Fundus photo.
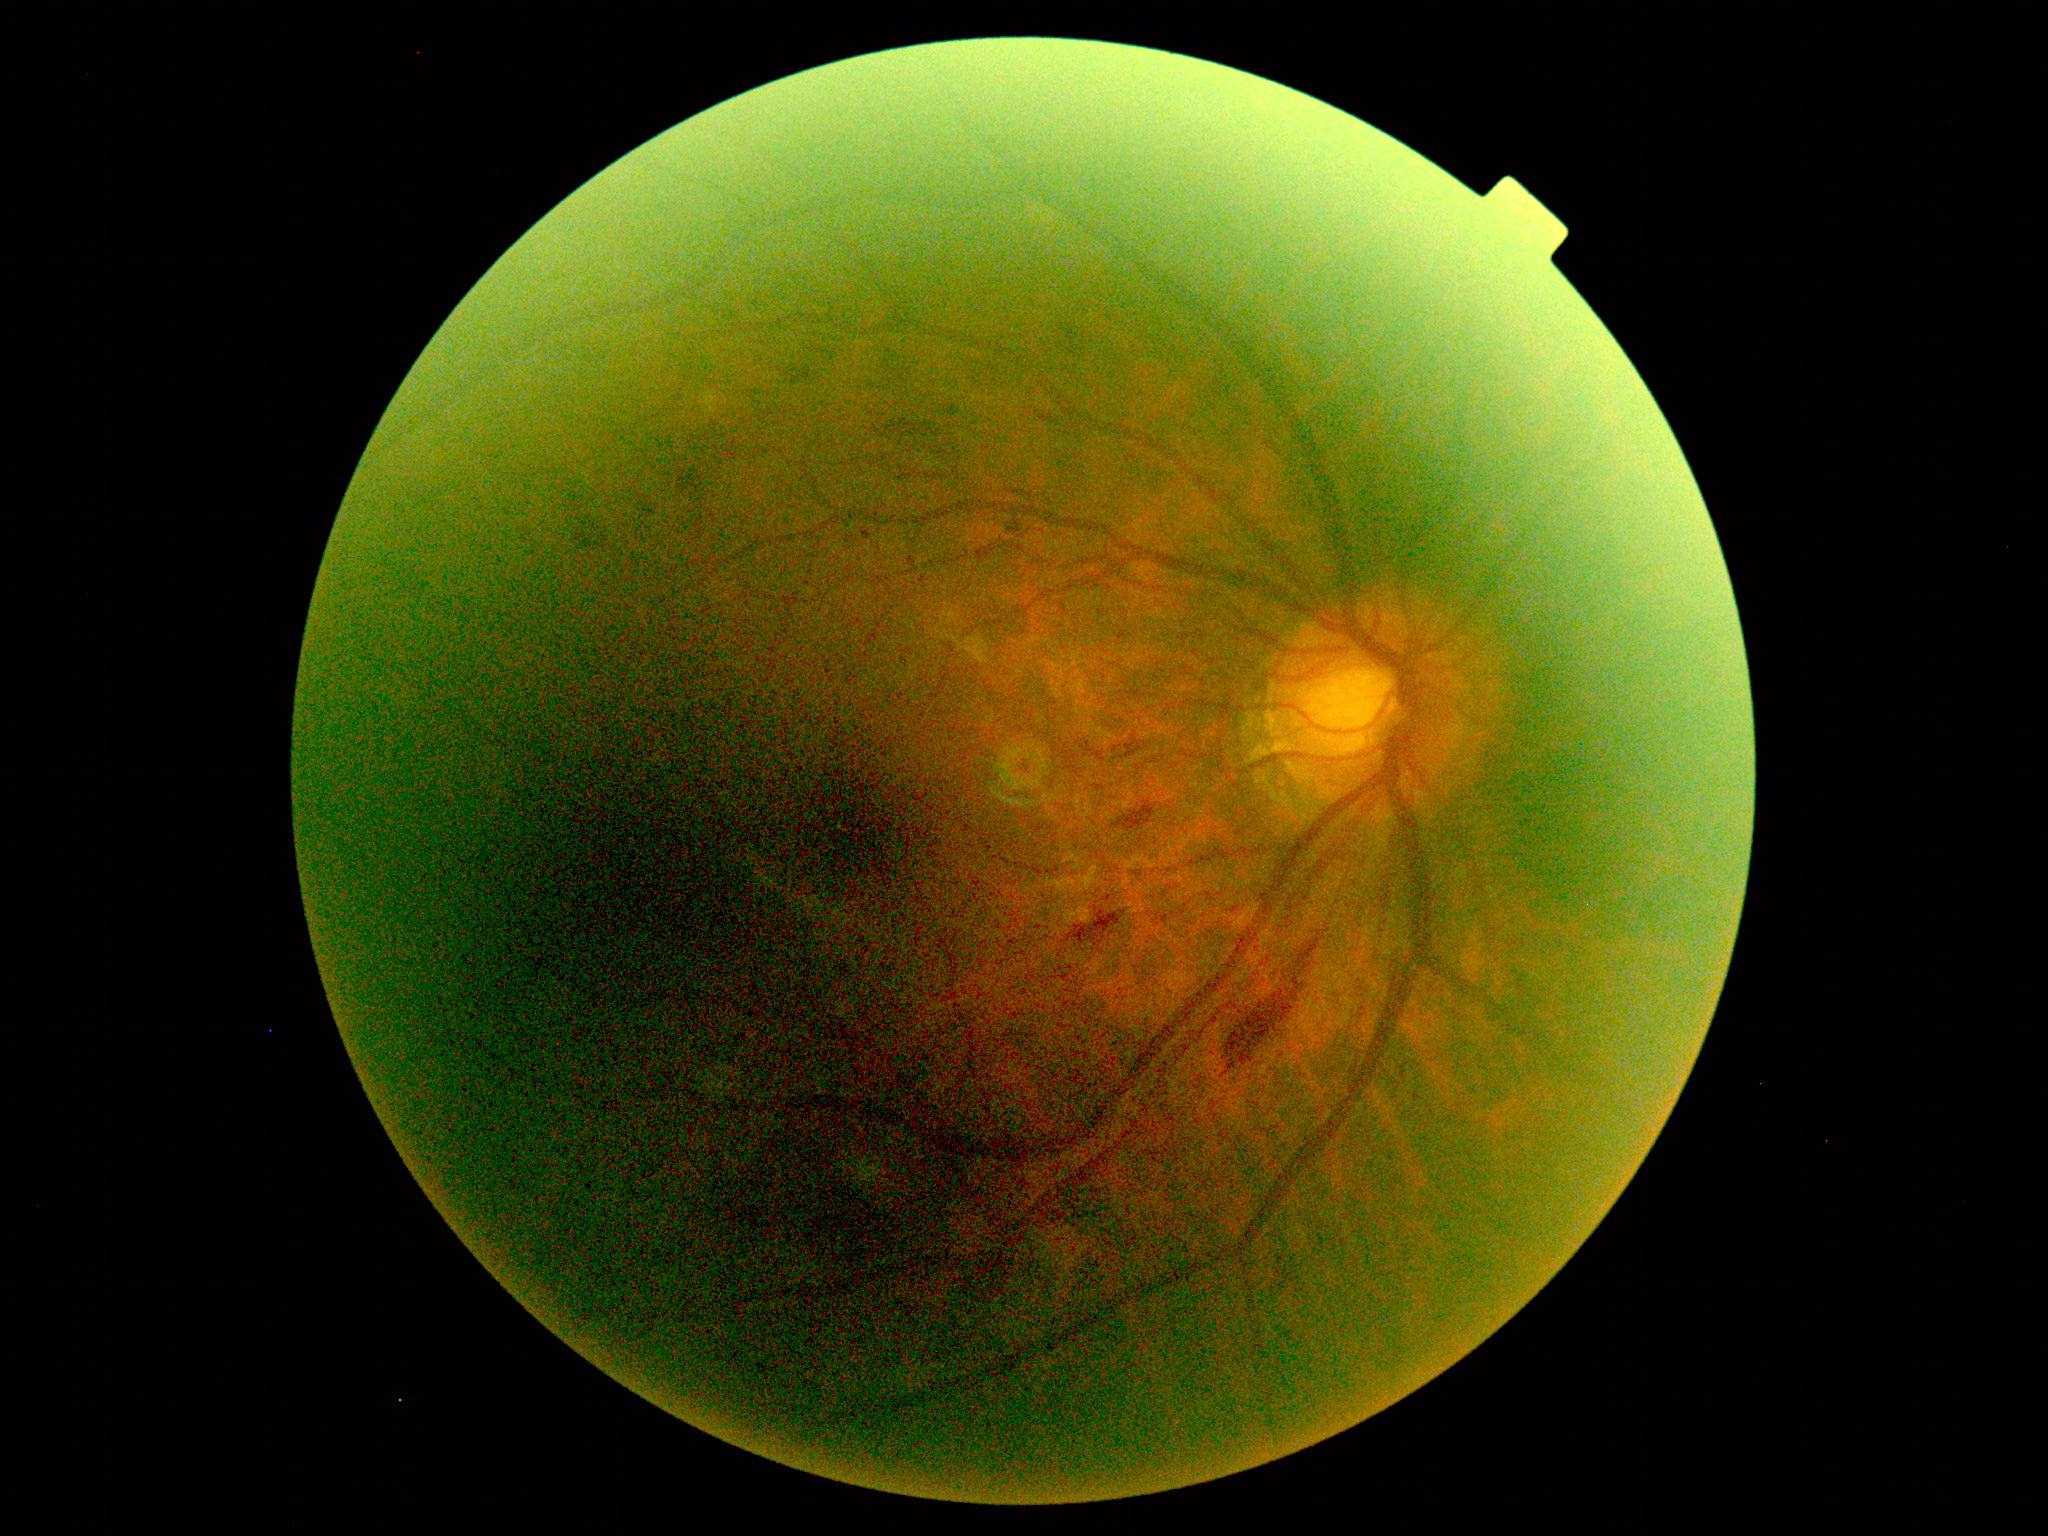

* DR grade: moderate non-proliferative diabetic retinopathy (2)